Camera: NIDEK AFC-230 · 848x848
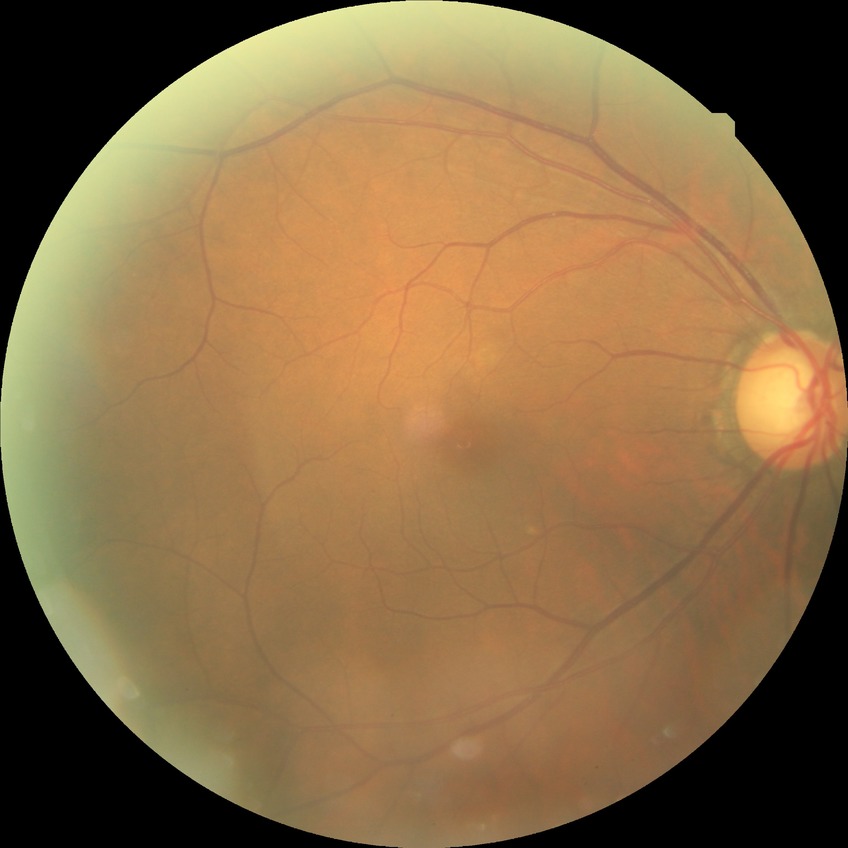
Diabetic retinopathy (DR): no diabetic retinopathy (NDR).